2048x1536px. 45-degree field of view: 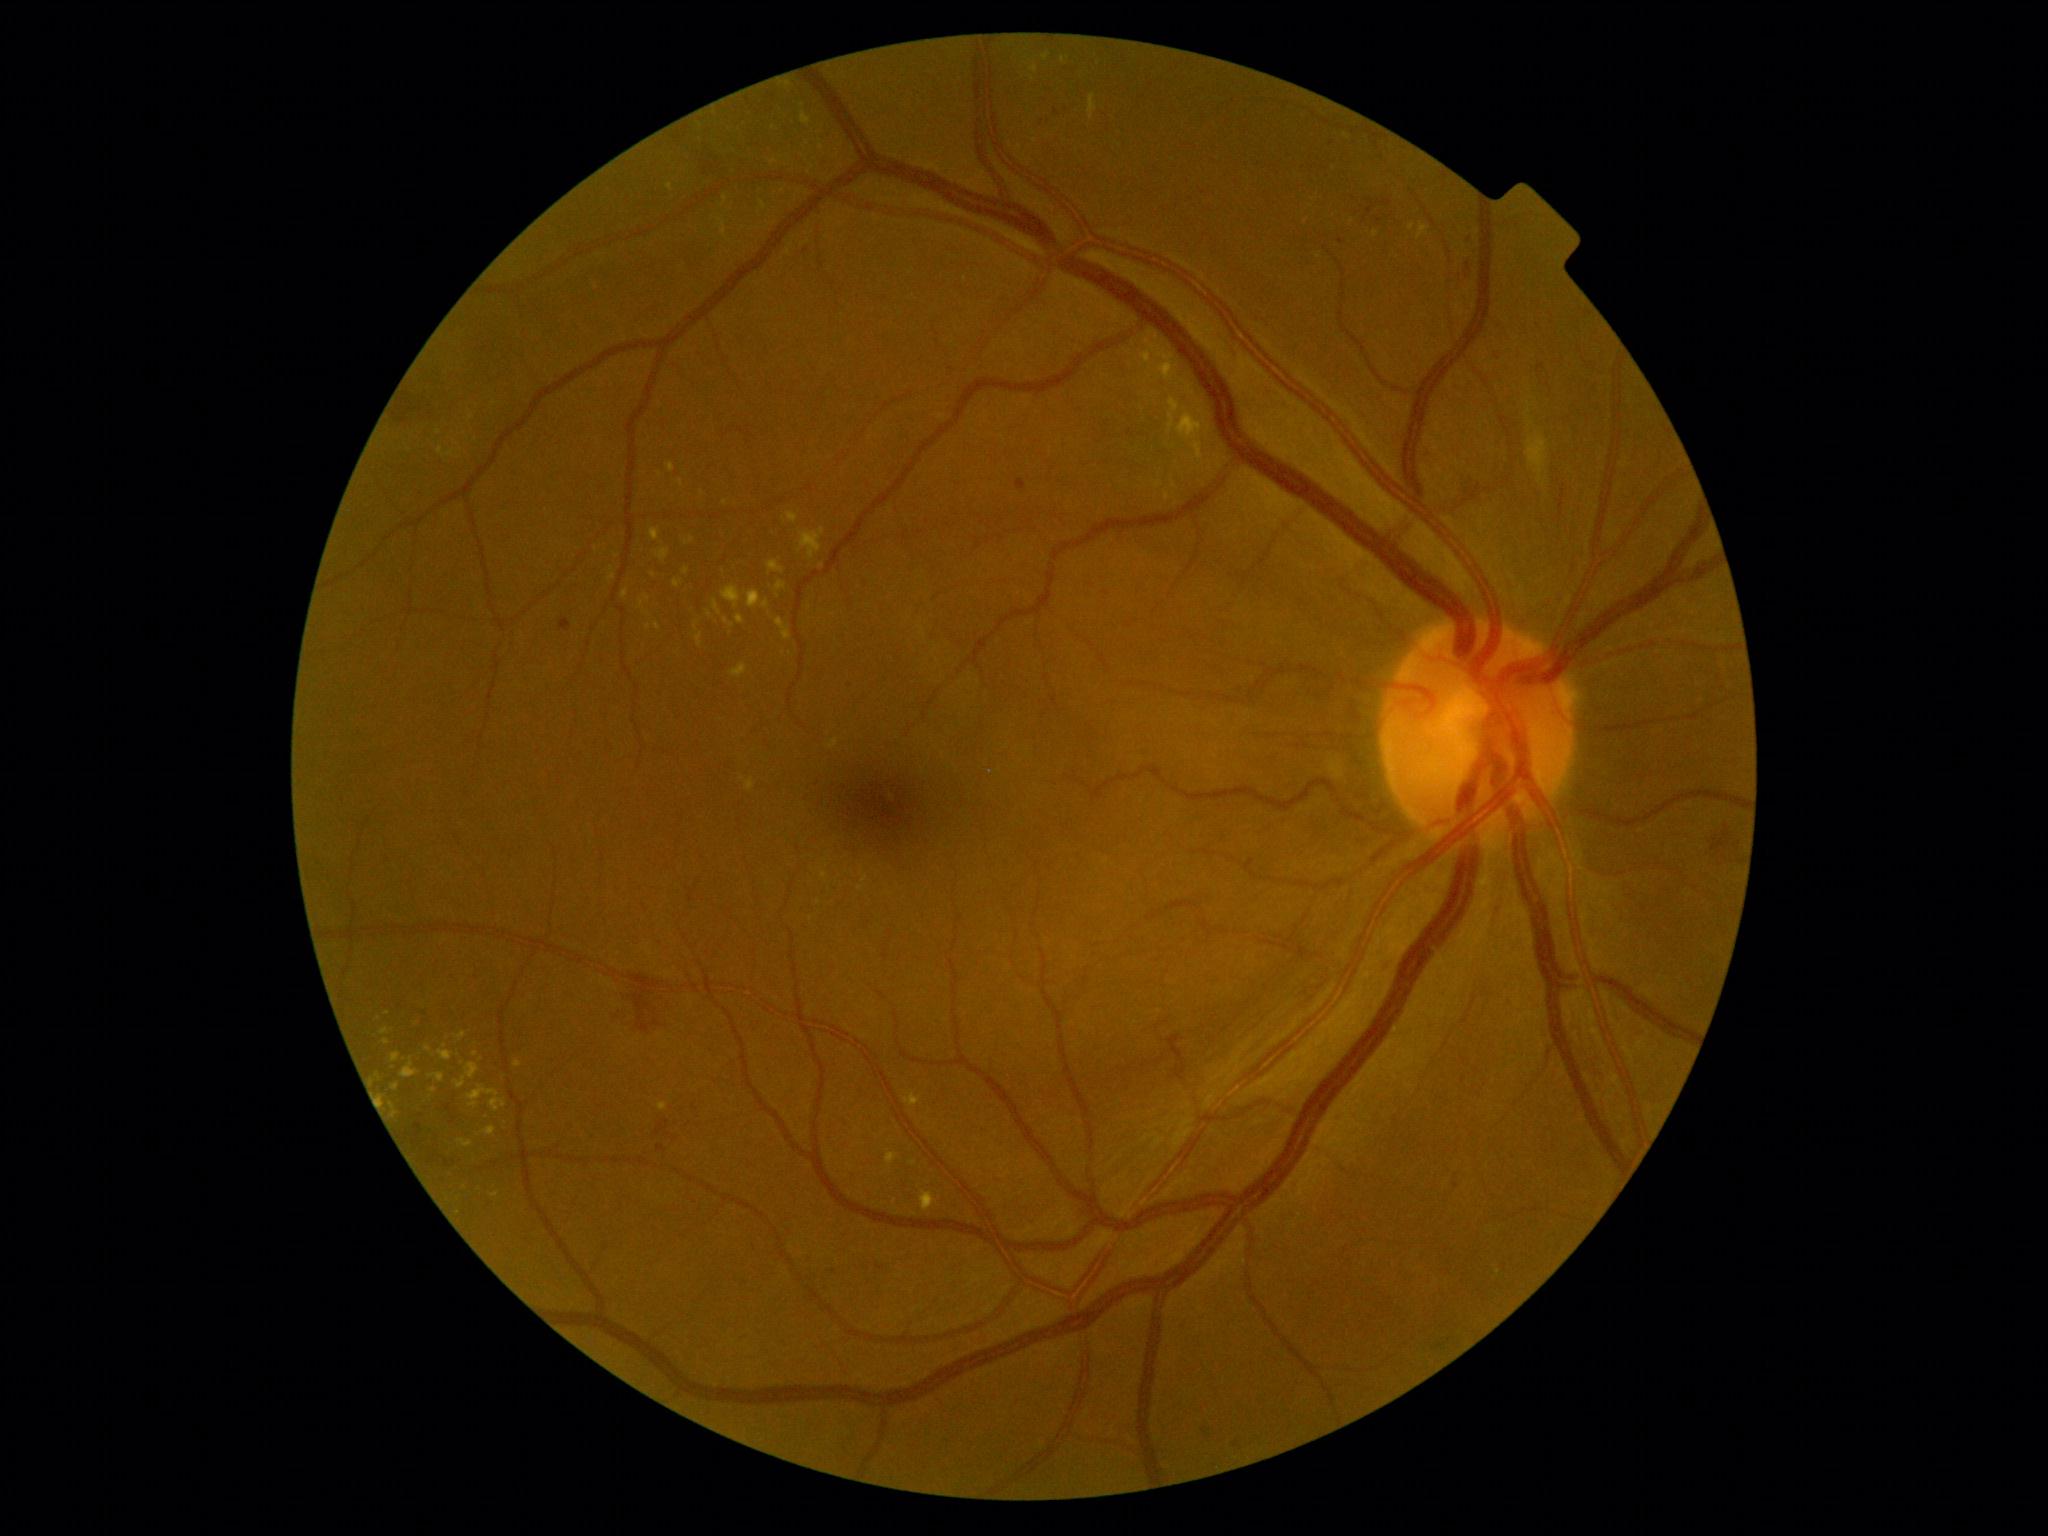
partial: true
dr_grade: 2
lesions:
  ex:
    - 391,1084,400,1091
    - 1089,95,1097,119
    - 667,463,675,473
    - 401,1059,419,1078
    - 457,1138,473,1148
    - 1149,335,1159,346
    - 746,779,754,791
    - 1043,54,1050,62
    - 786,512,799,523
    - 799,529,825,561
    - 430,1074,444,1083
  ex_small_approx:
    - (x=818, y=902)
    - (x=647, y=598)
    - (x=433, y=1090)
    - (x=913, y=1163)
    - (x=1063, y=60)
    - (x=726, y=503)
    - (x=825, y=875)
    - (x=596, y=550)